848x848.
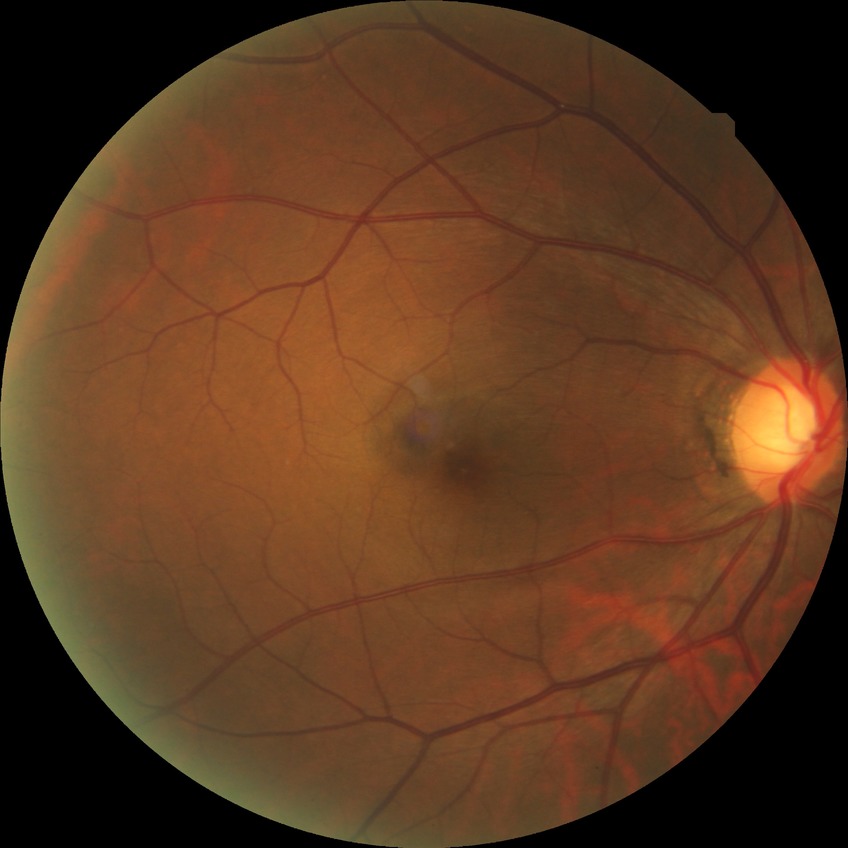

DR impression: no apparent DR; DR severity: NDR.